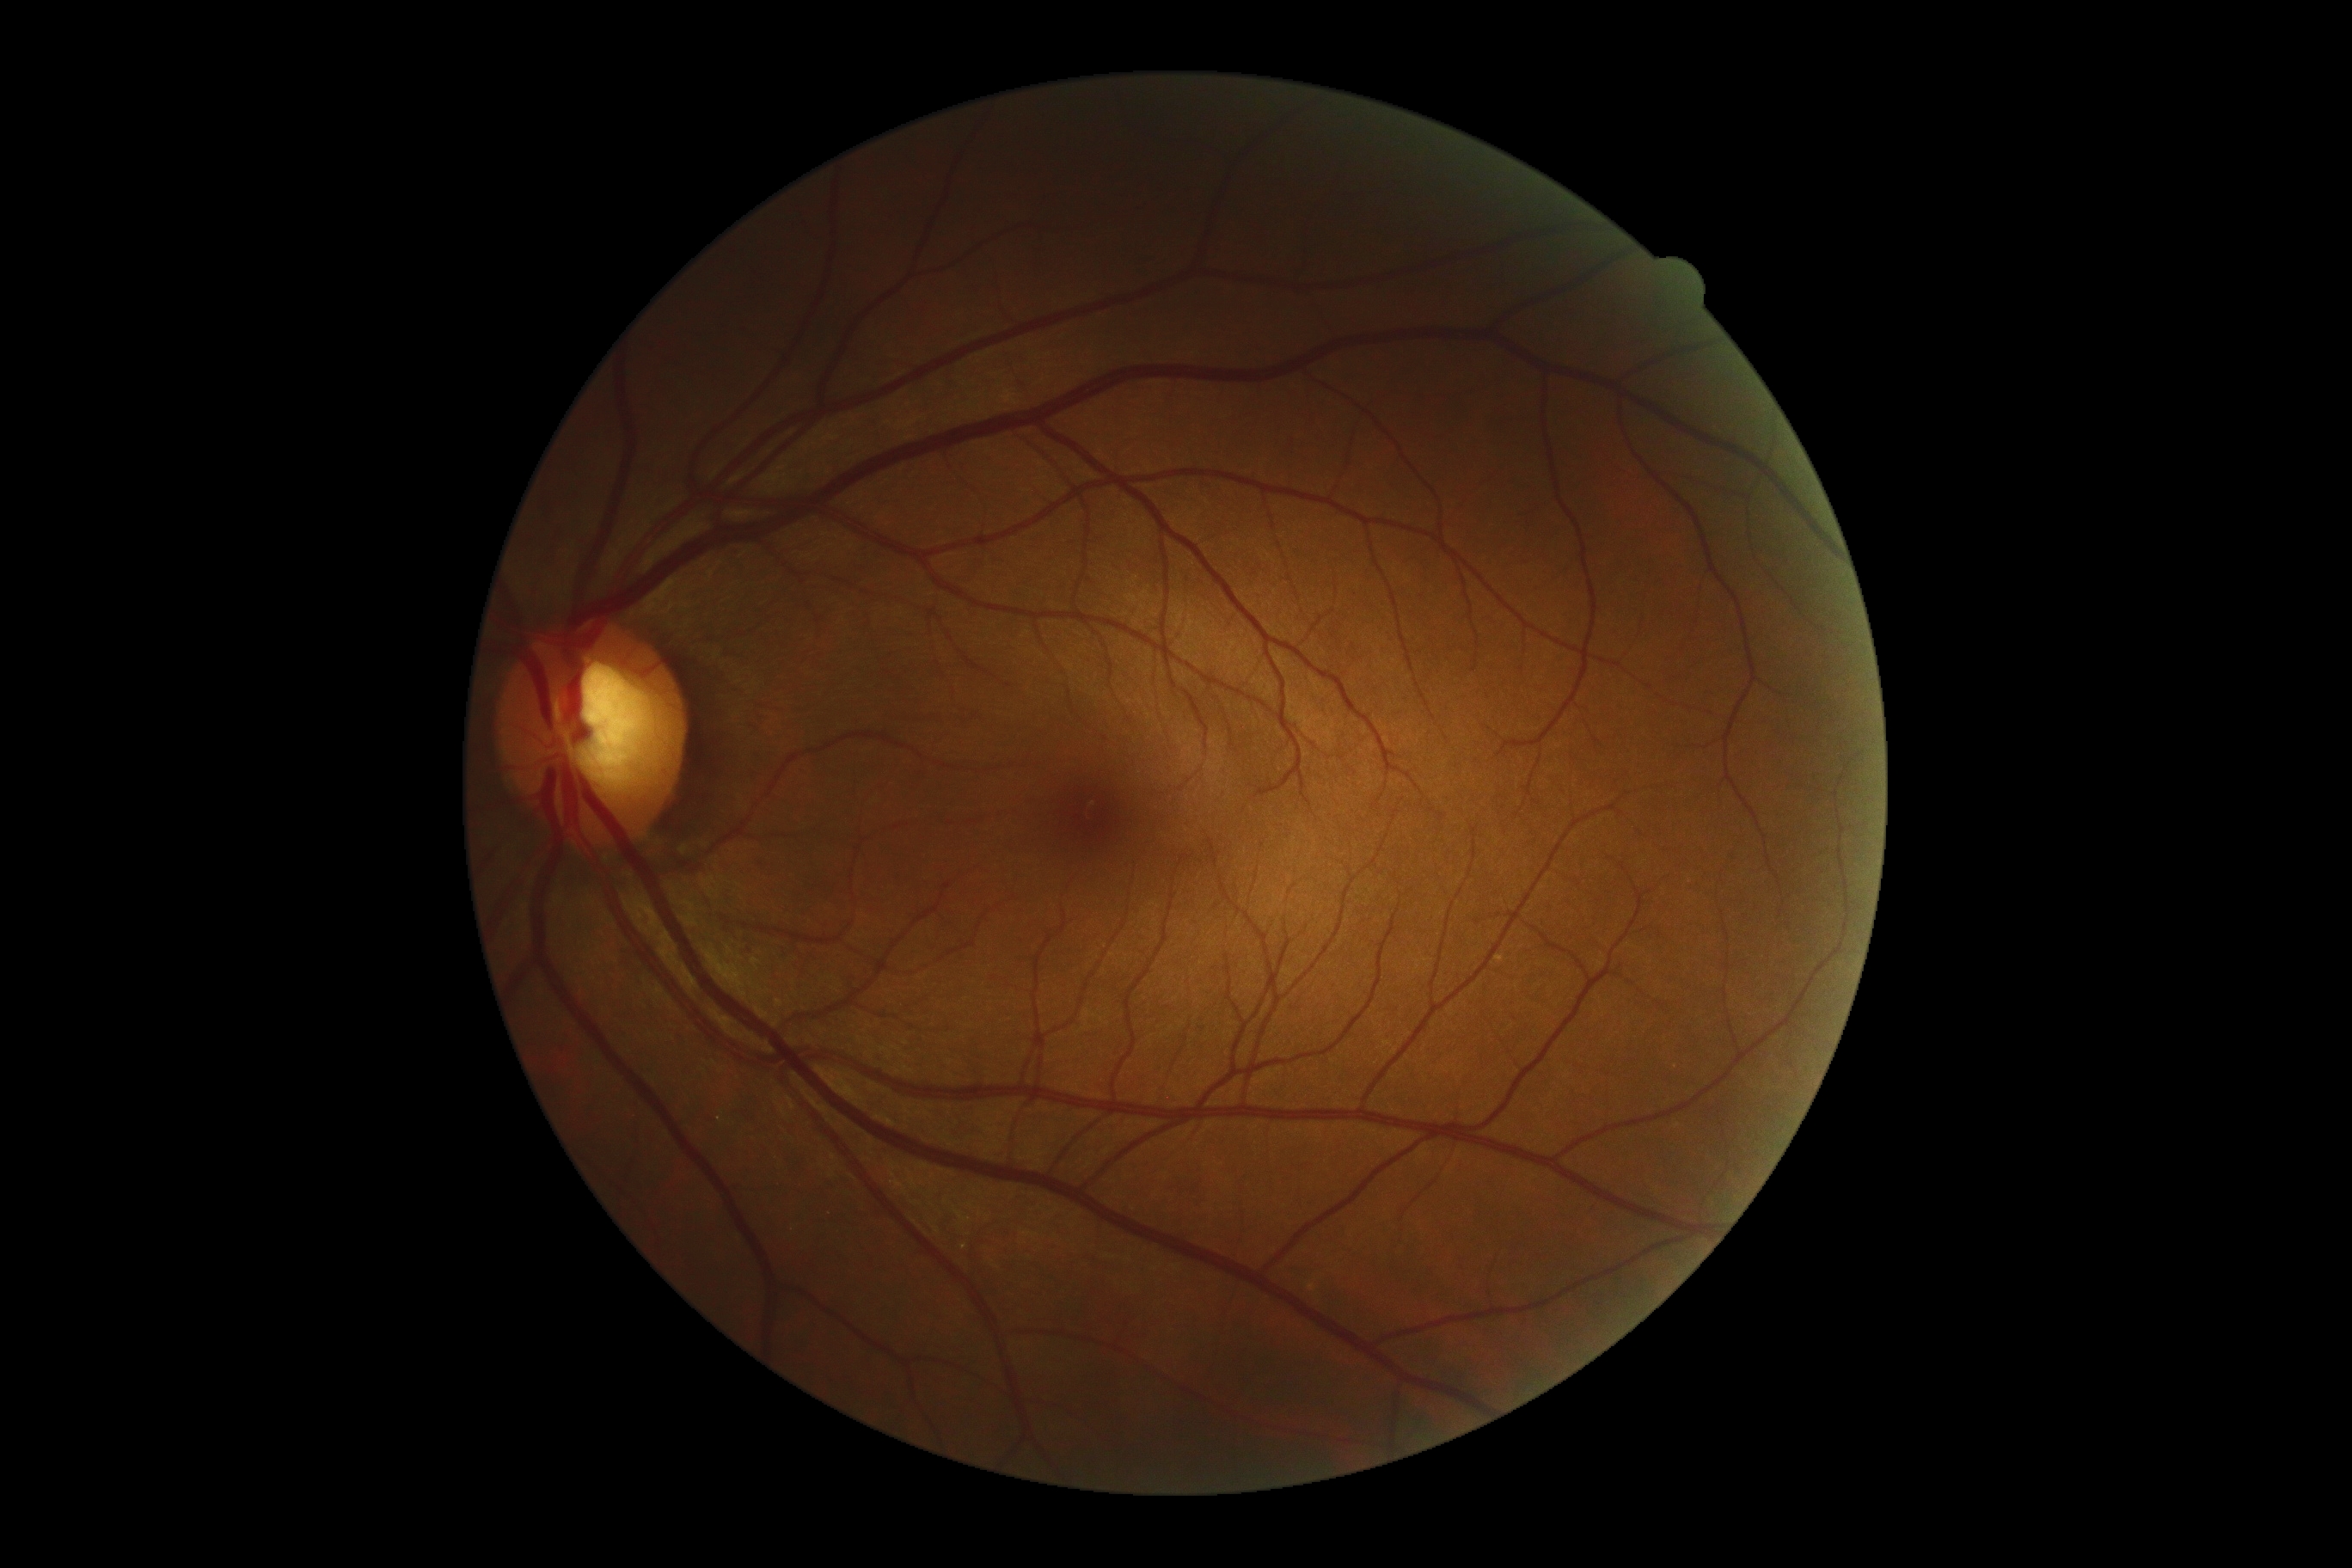

{
  "dr_grade": "grade 0 (no apparent retinopathy) — no visible signs of diabetic retinopathy"
}